45 degree fundus photograph; 848 by 848 pixels:
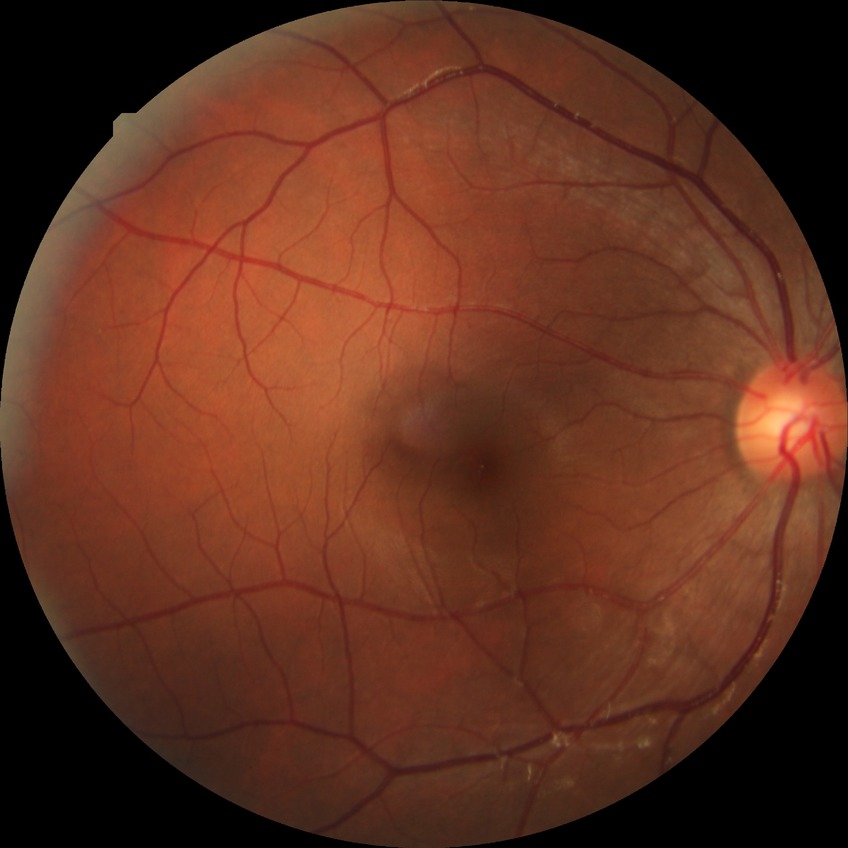 Diabetic retinopathy (DR): NDR (no diabetic retinopathy).